2048 x 1536 pixels.
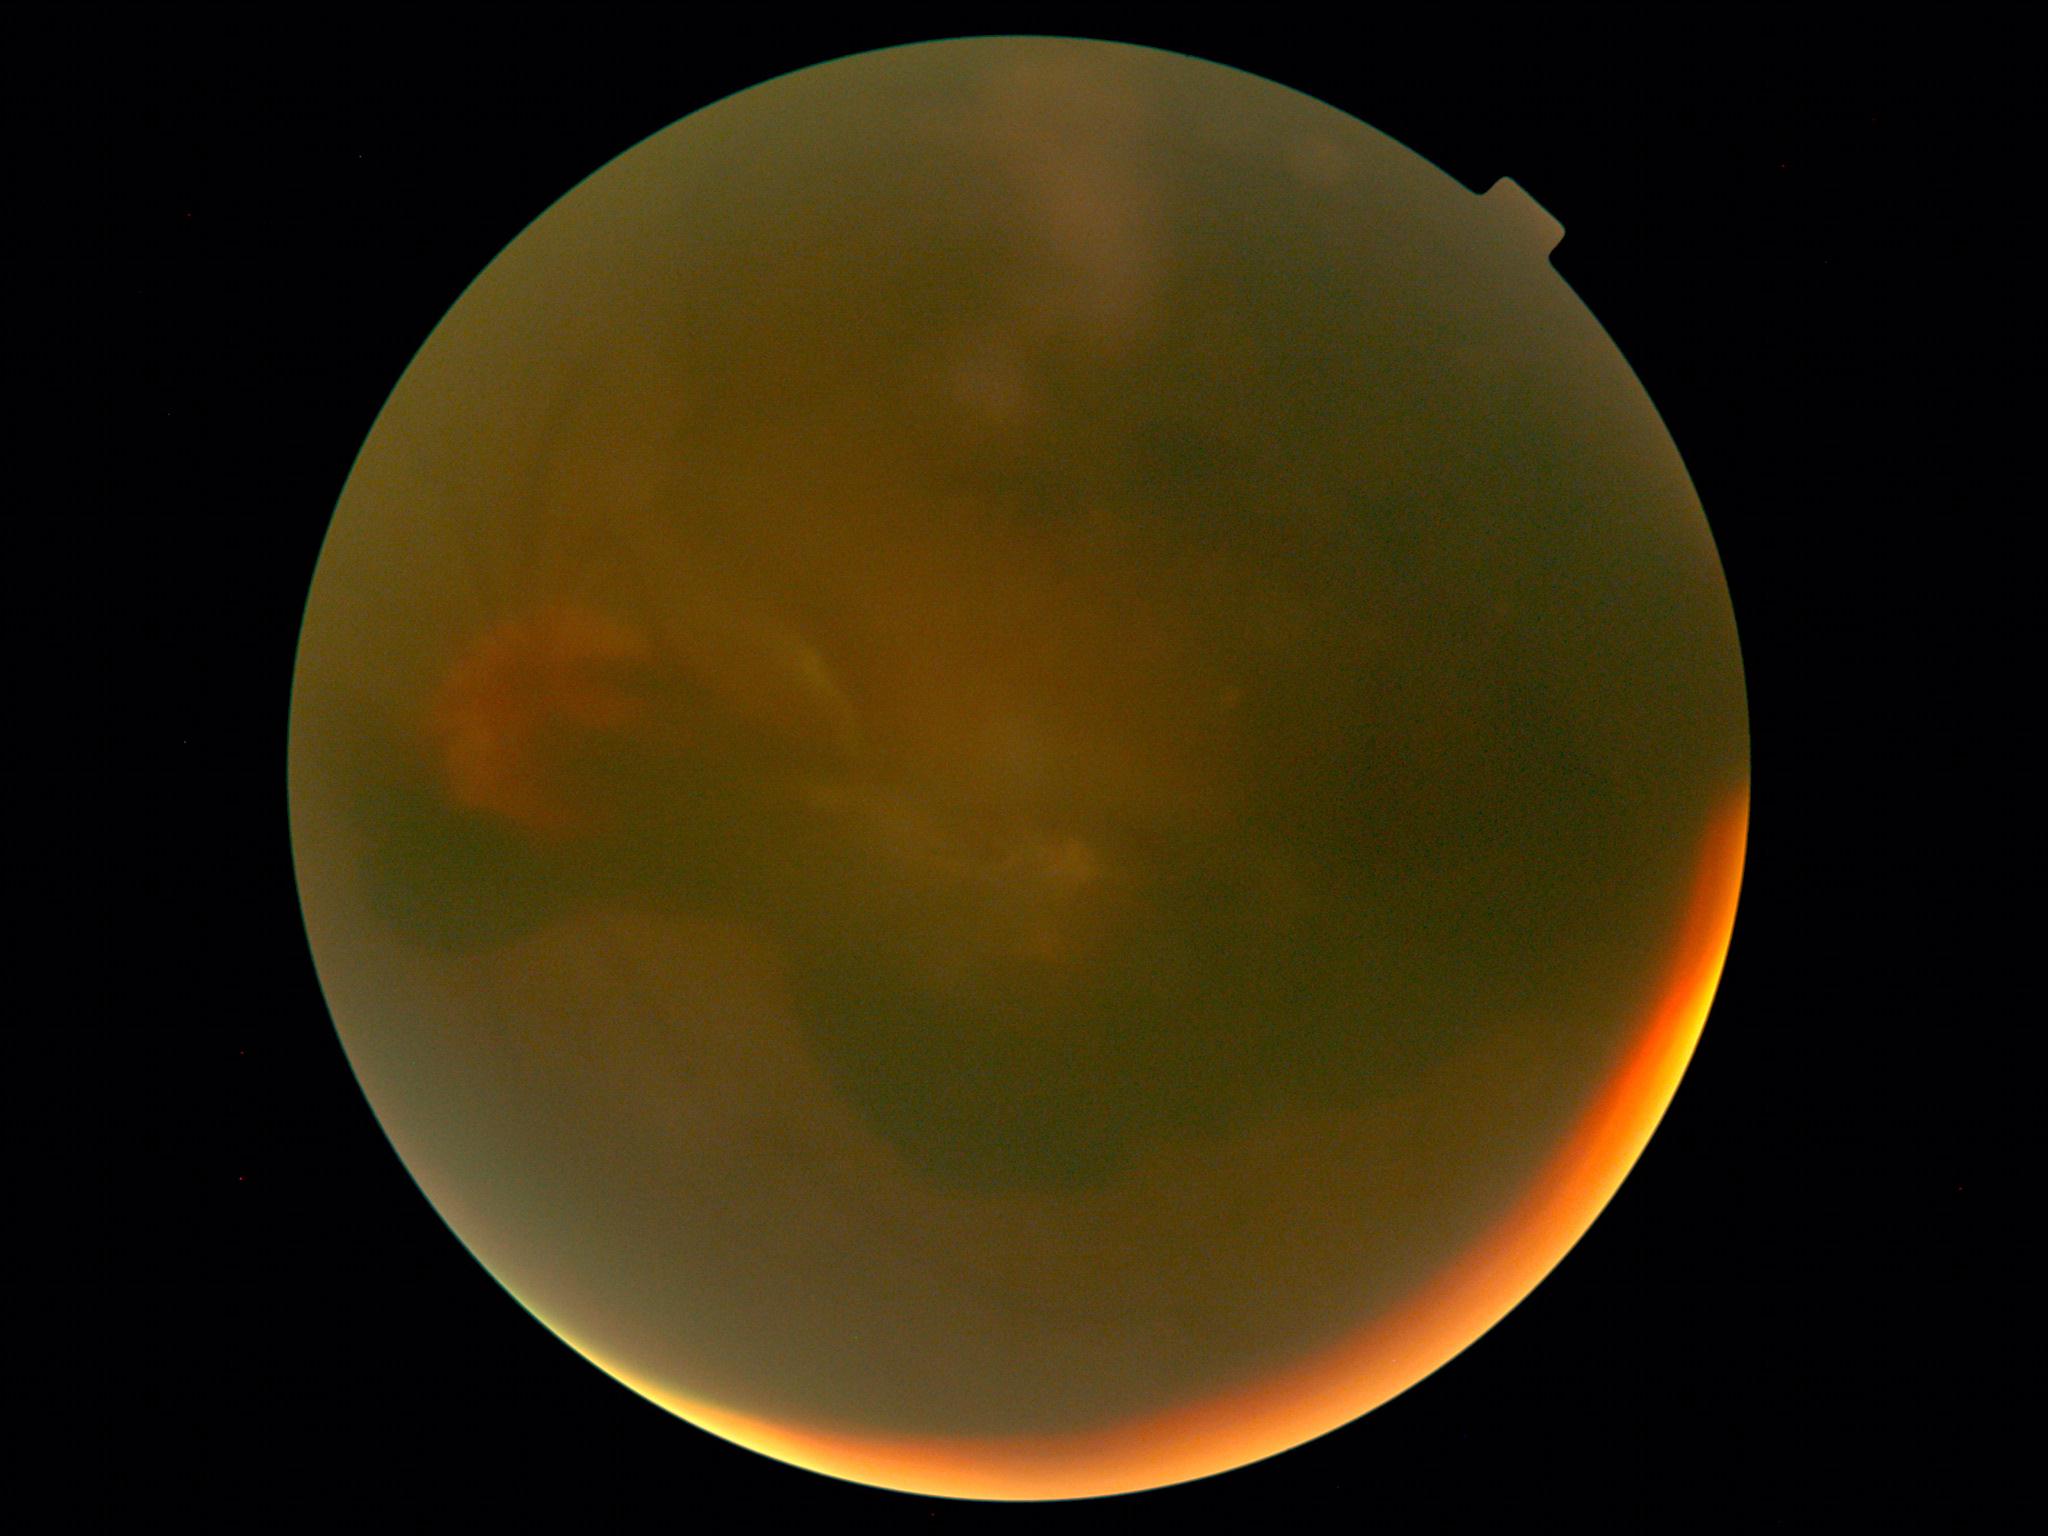
{"dr_grade": "proliferative diabetic retinopathy (grade 4) — neovascularization and/or vitreous/pre-retinal hemorrhage", "dr_category": "proliferative diabetic retinopathy"}